Wide-field contact fundus photograph of an infant
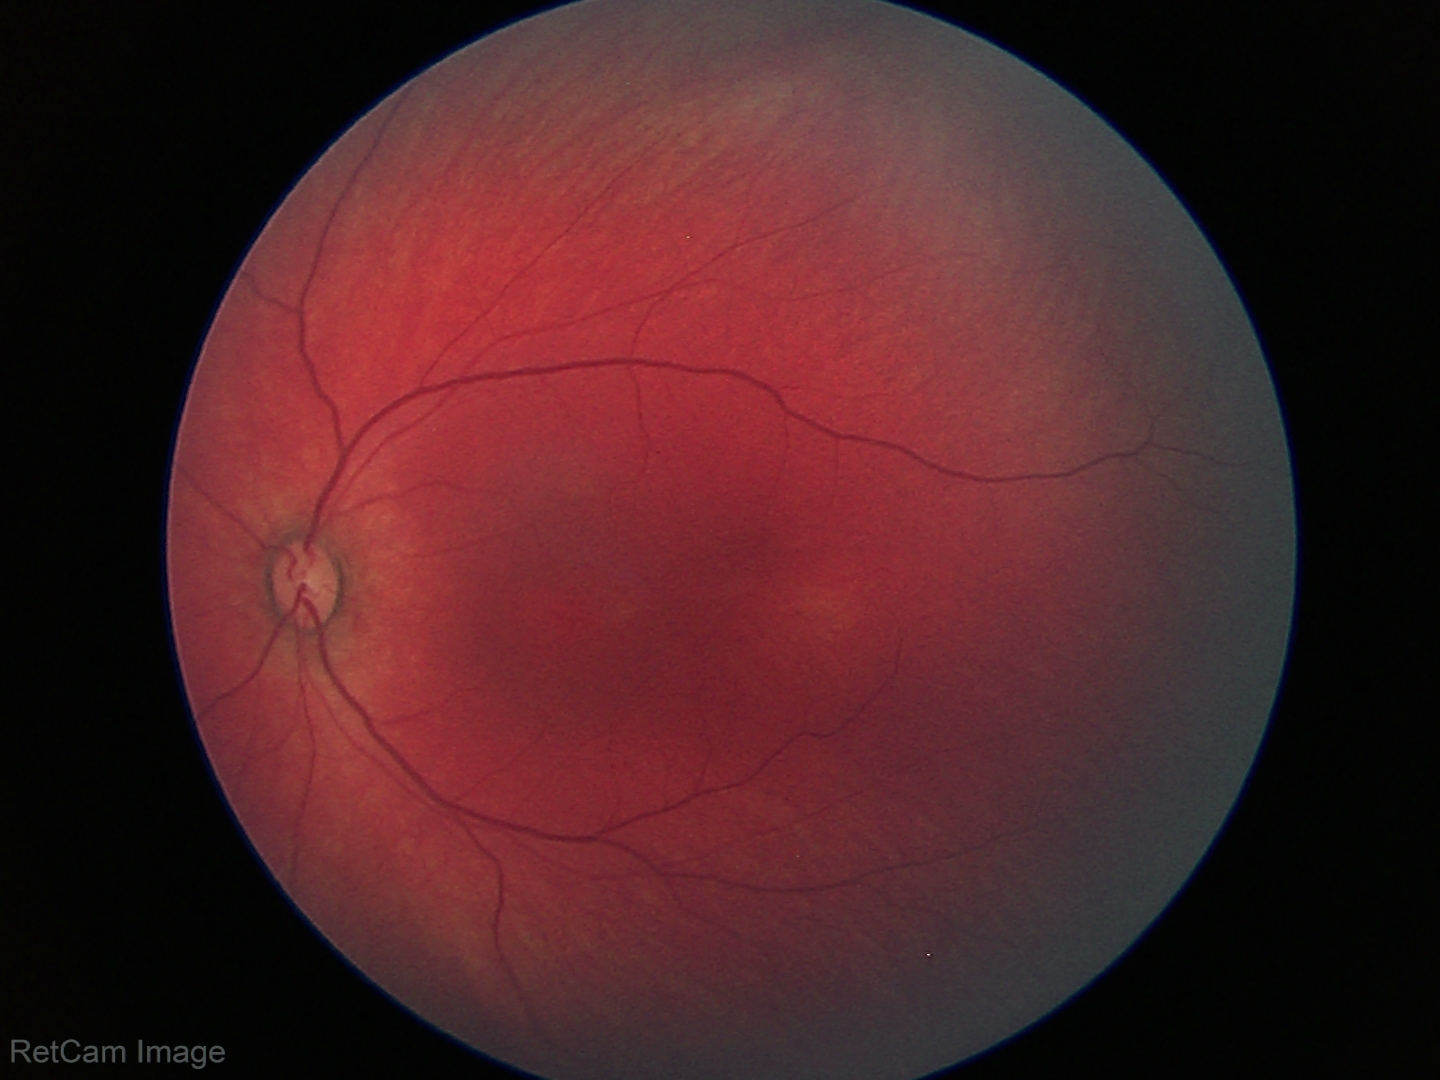
Examination with physiological retinal findings.